DR severity per modified Davis staging.
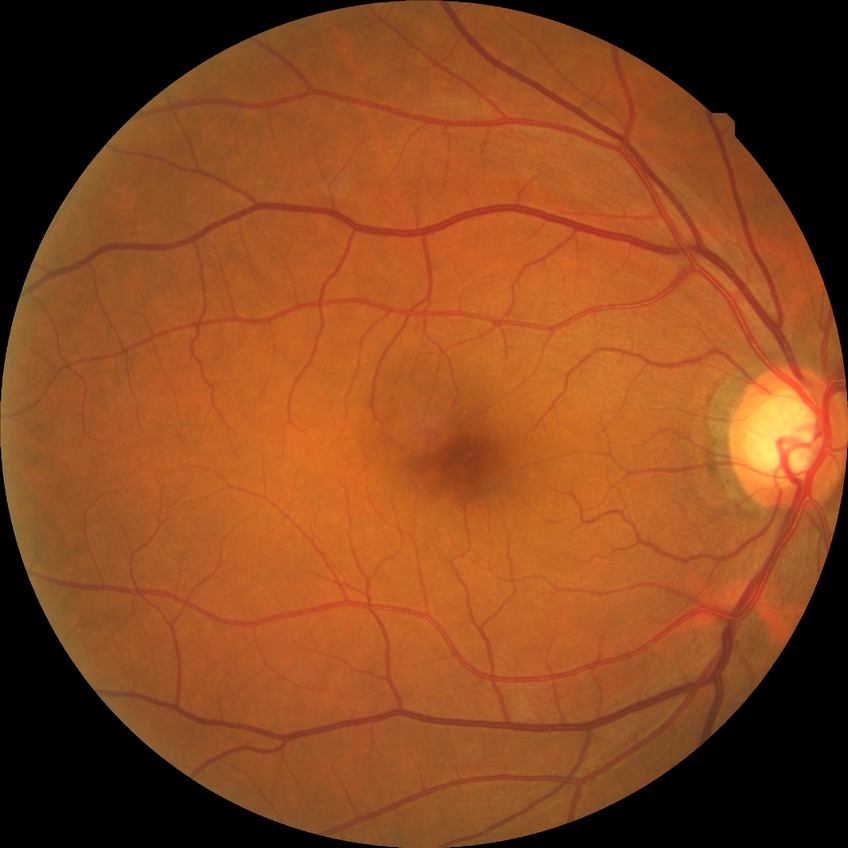

Retinopathy stage: no diabetic retinopathy.